Centered on the macula; dilated-pupil acquisition; 50° FOV
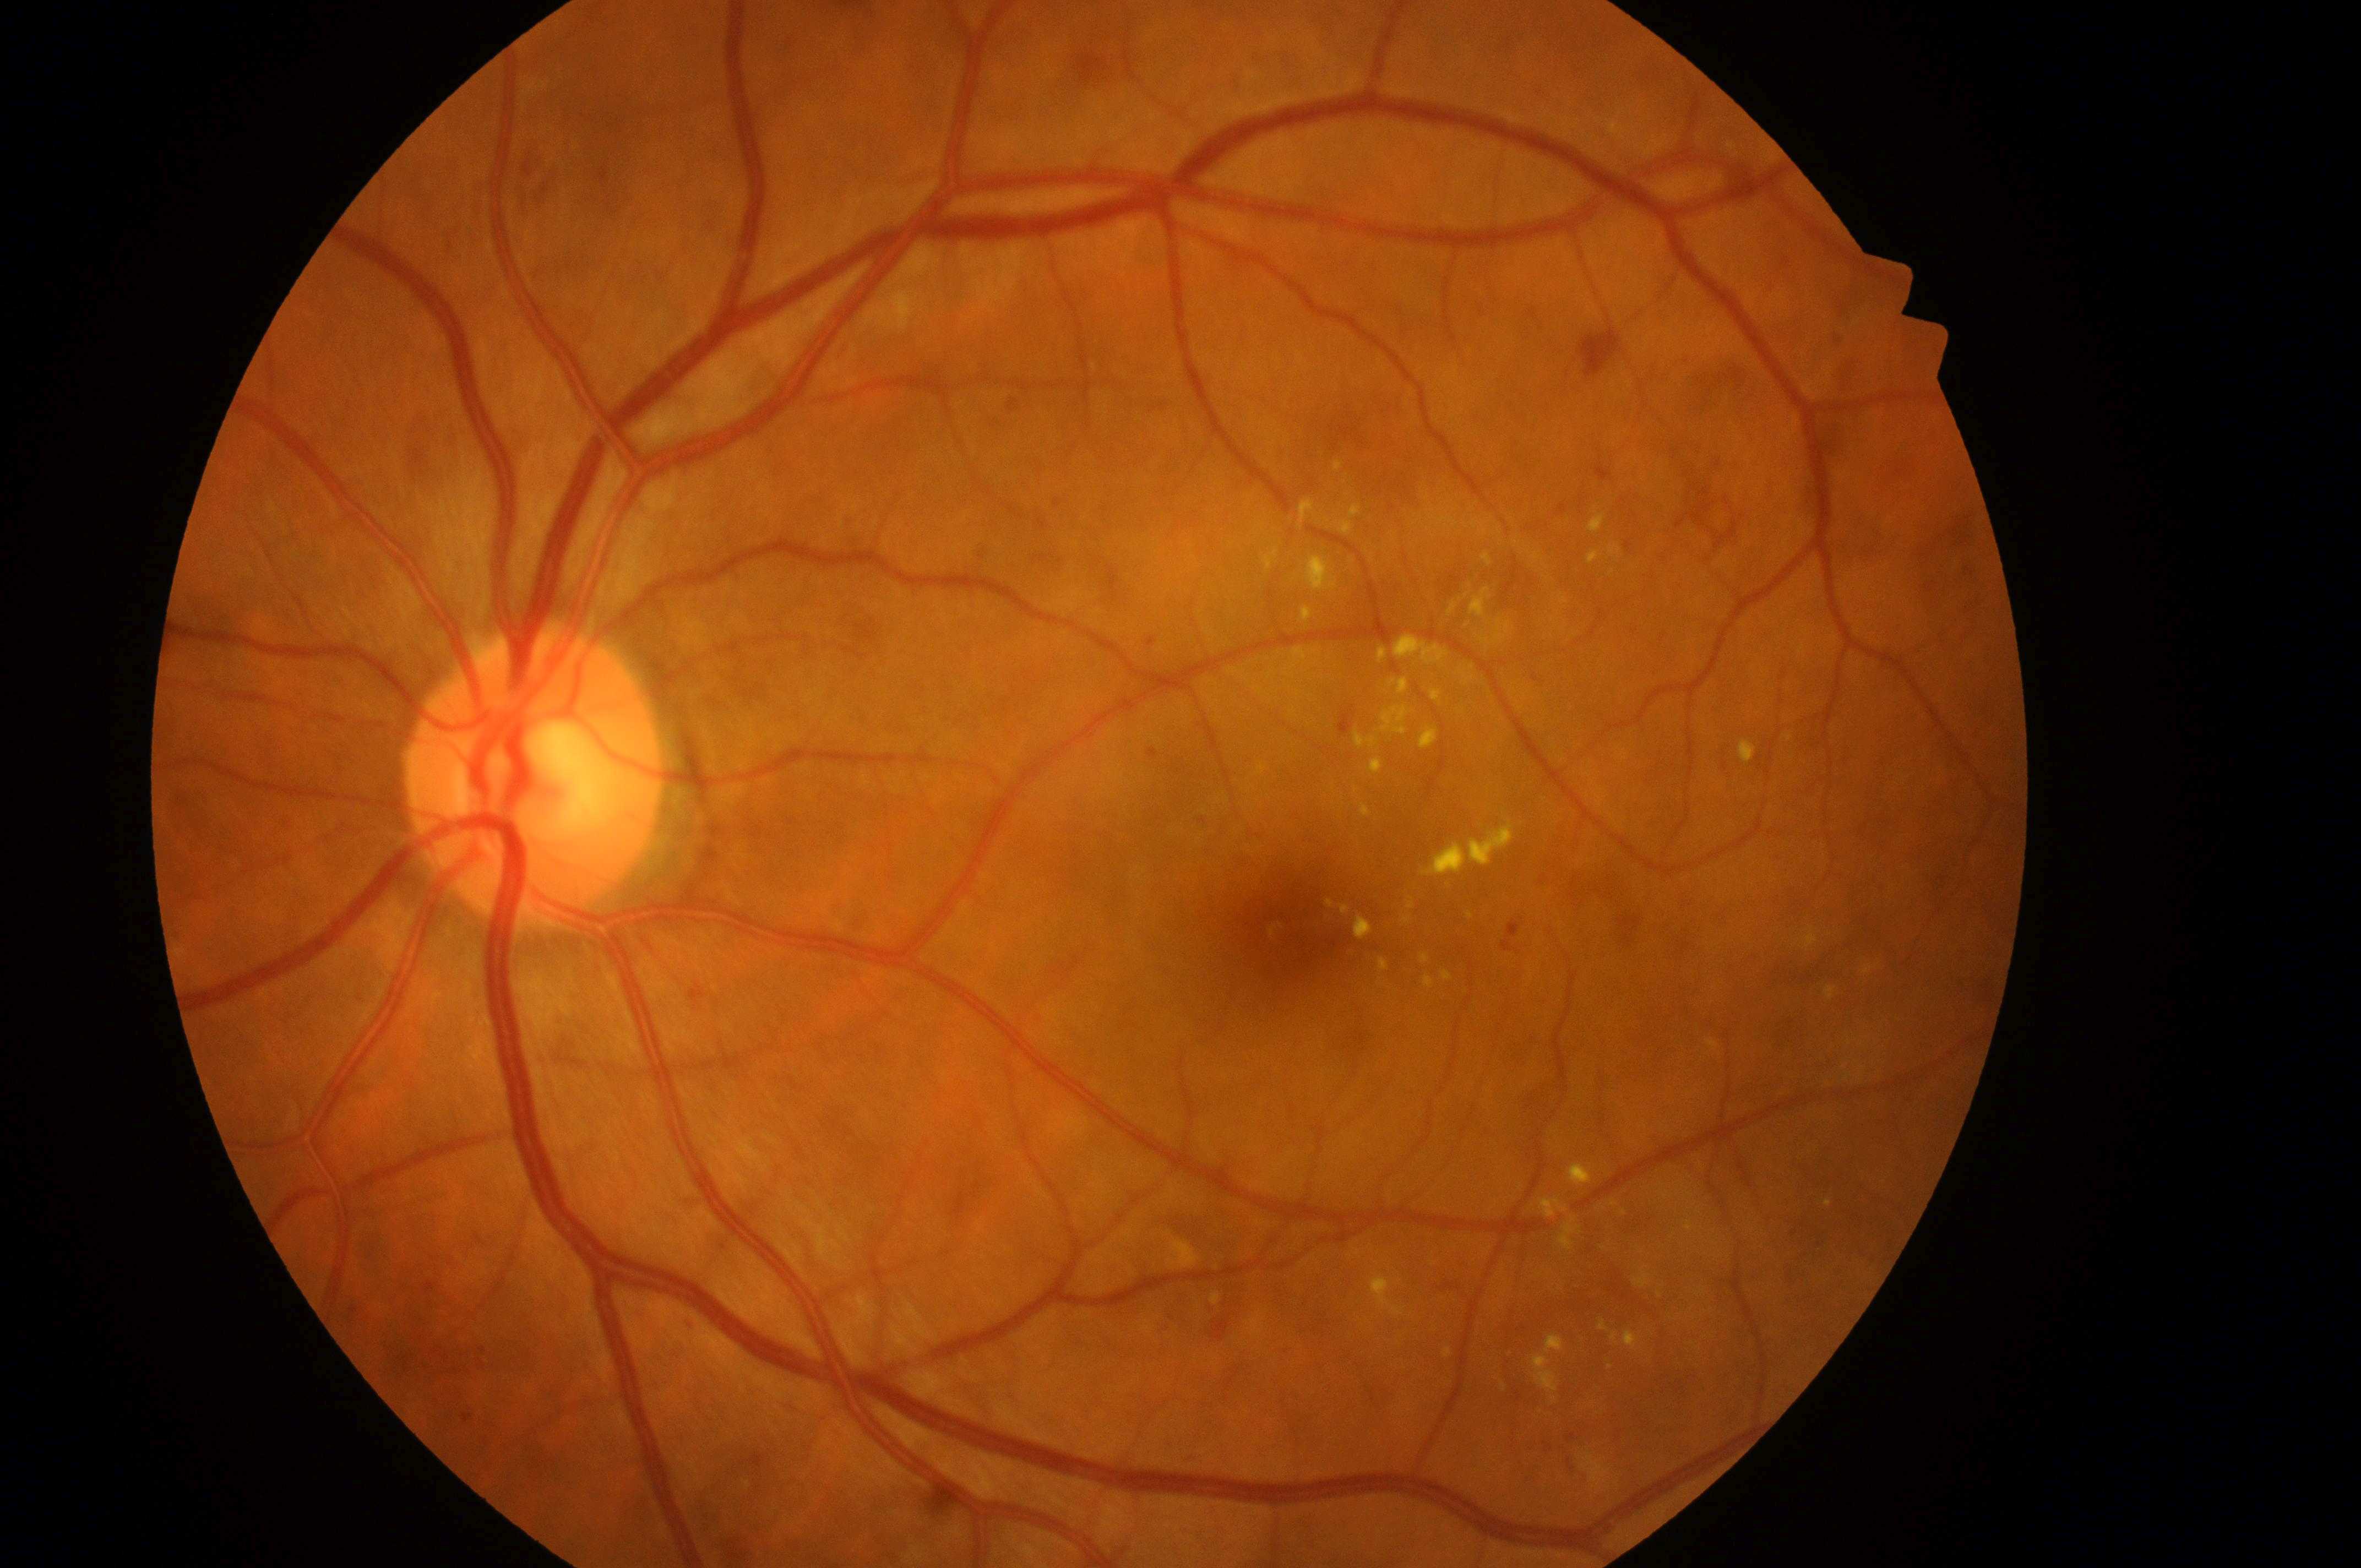
• diabetic retinopathy (DR): grade 2 (moderate NPDR) — more than just microaneurysms but less than severe NPDR
• optic disc center: (x=526, y=785)
• diabetic macular edema (DME): grade 2 (high risk) — hard exudates within one disc diameter of the macula center
• foveal center: (x=1293, y=930)
• laterality: left